30-degree field of view · retinal fundus photograph.
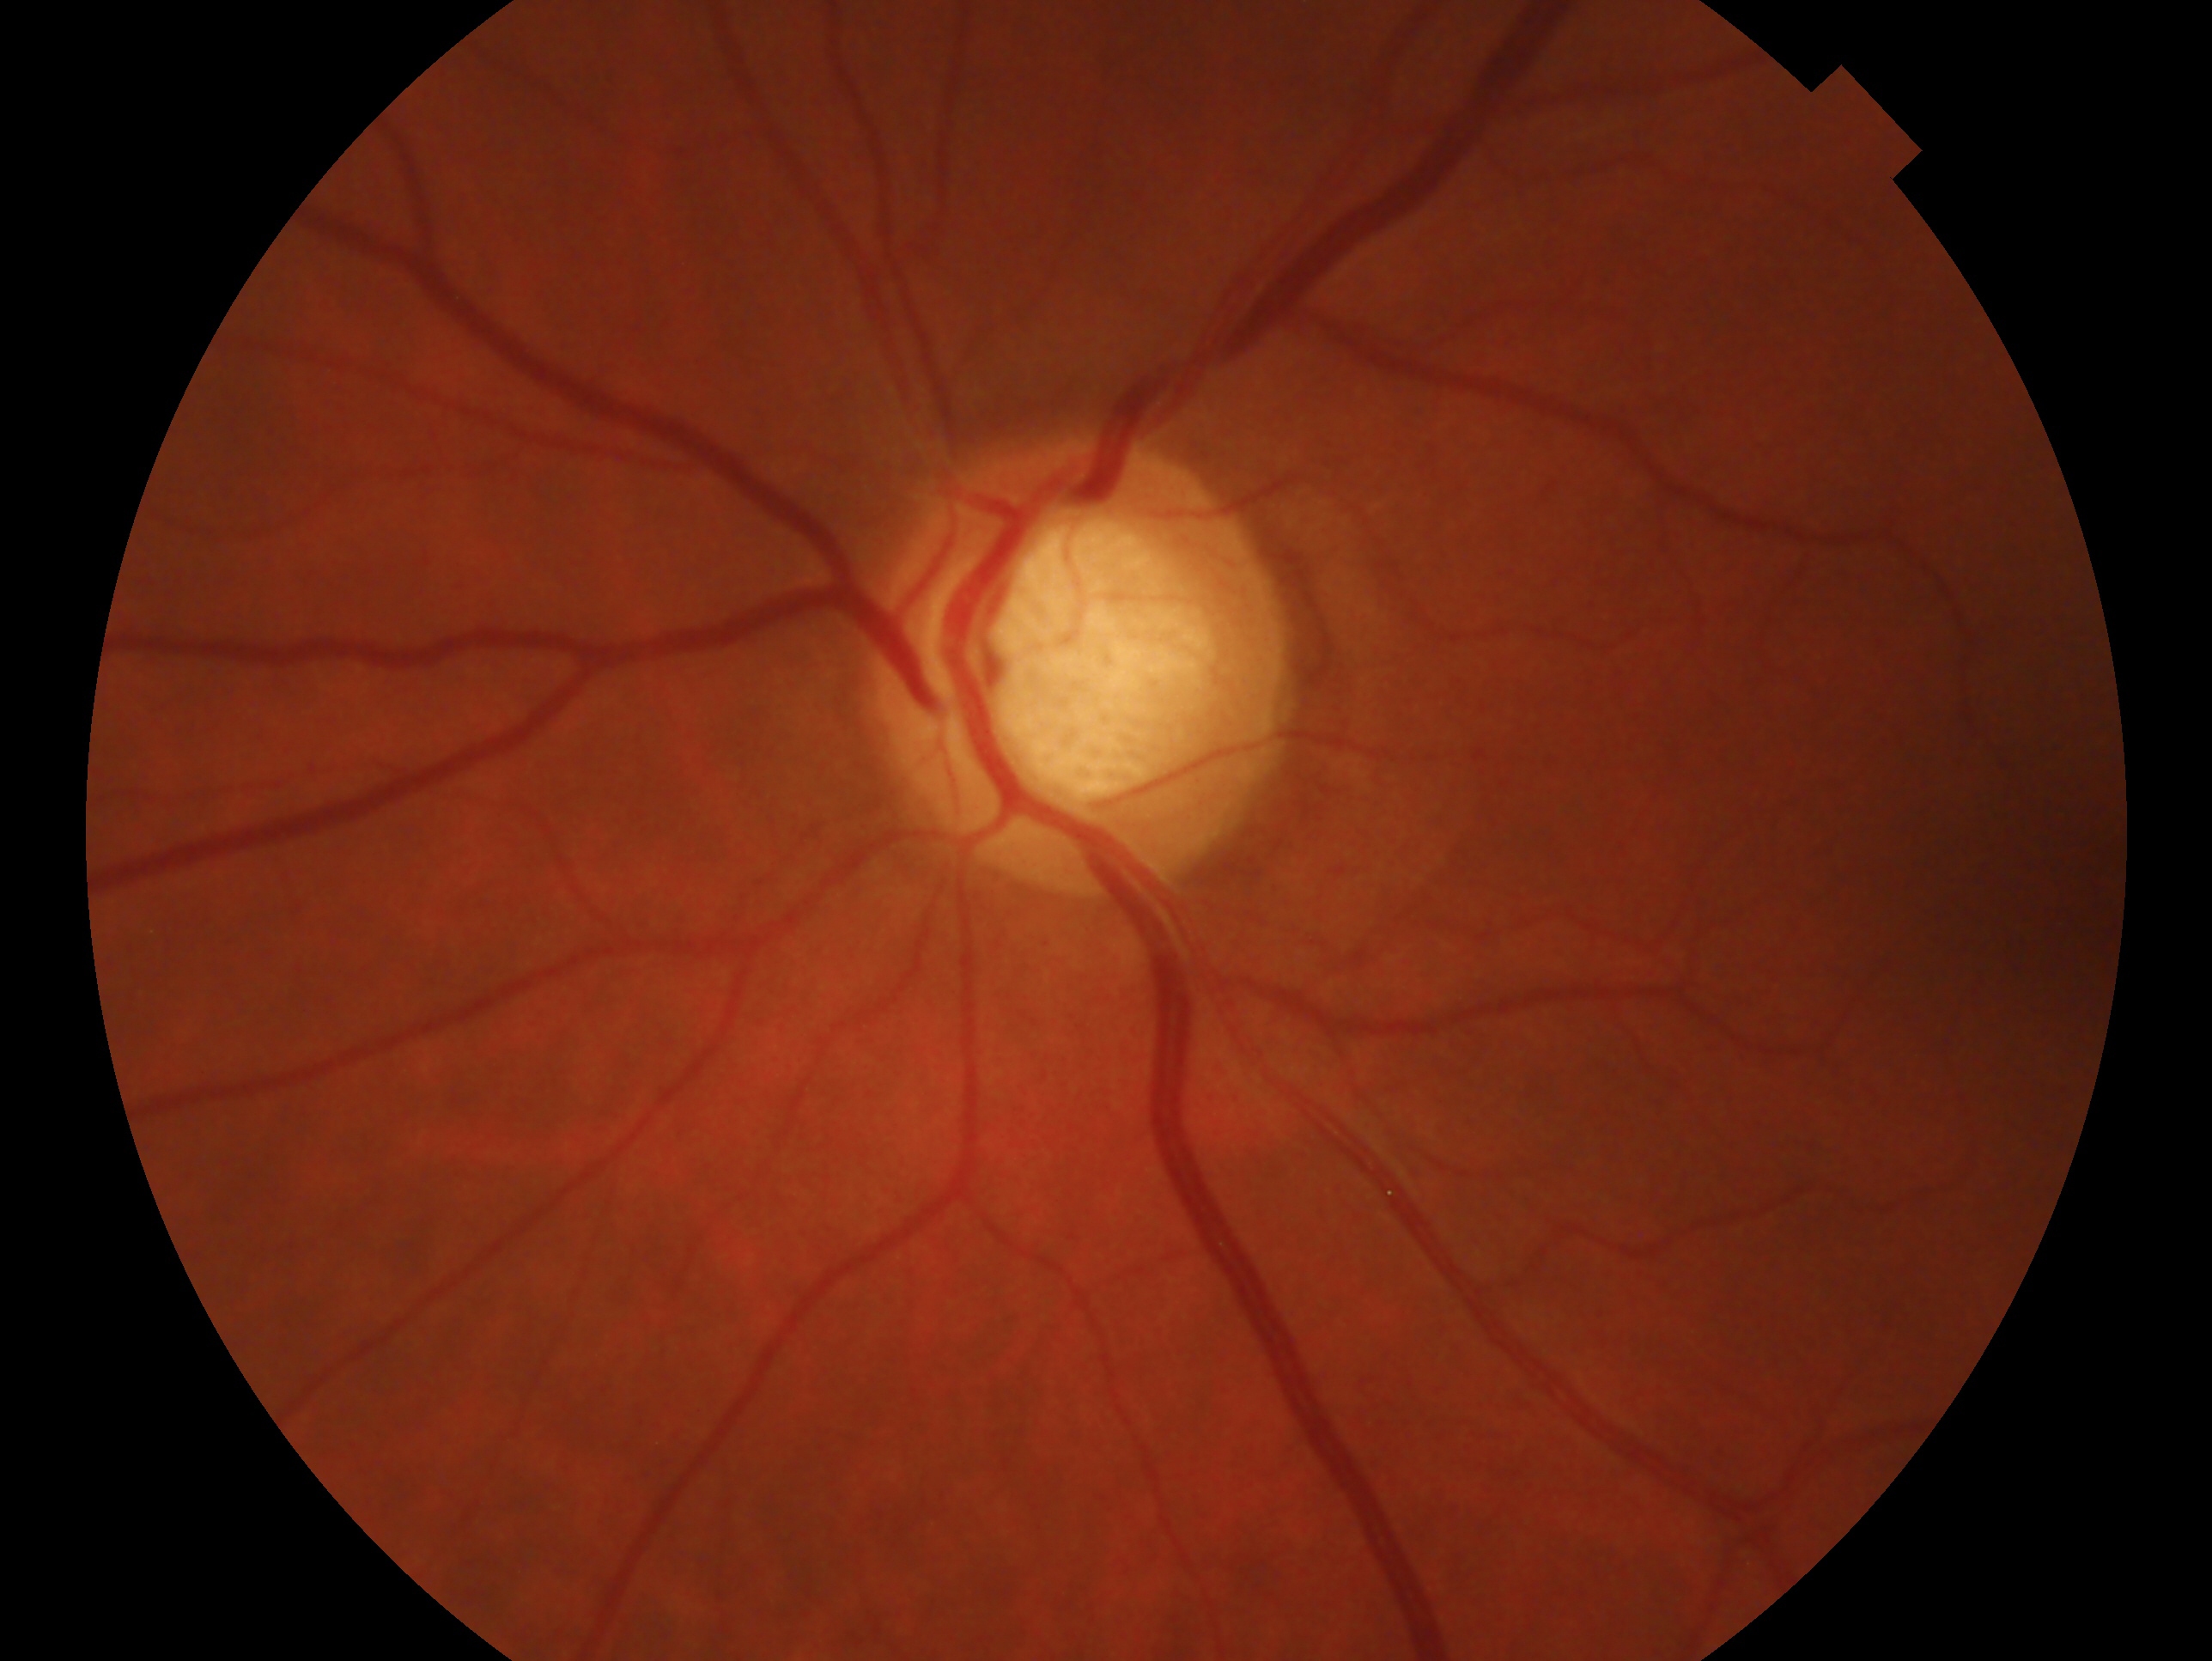 Glaucoma diagnosis: glaucoma. The image shows the left eye.